Image size 1240x1240. Pediatric retinal photograph (wide-field)
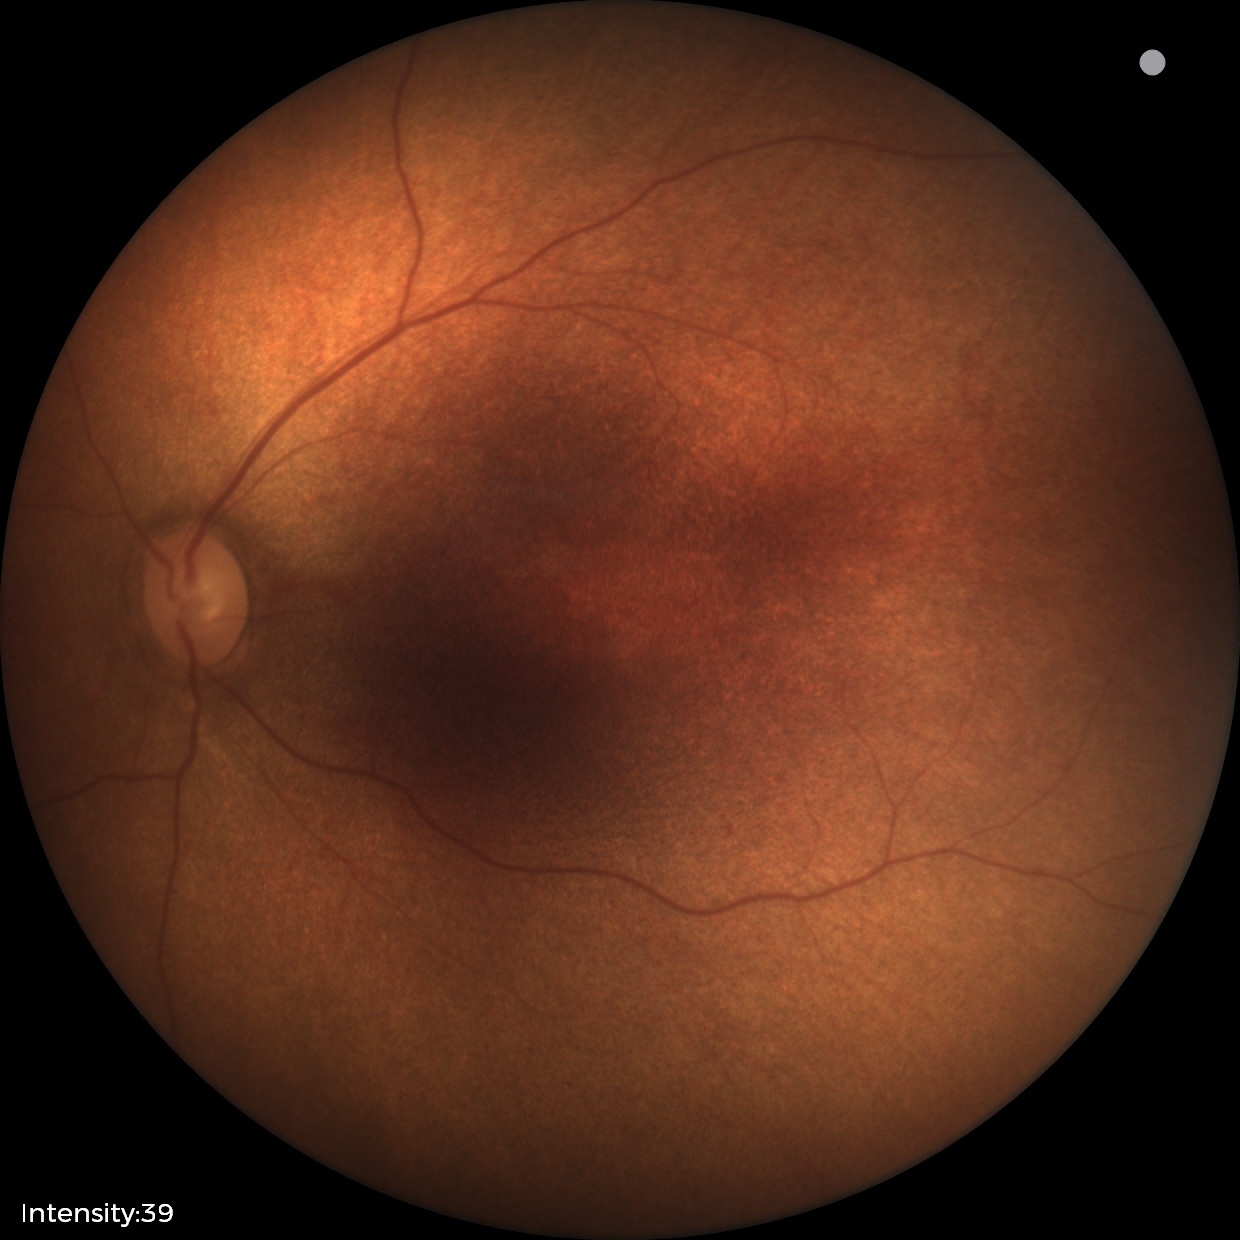 Q: What is the screening diagnosis?
A: no abnormal retinal findings